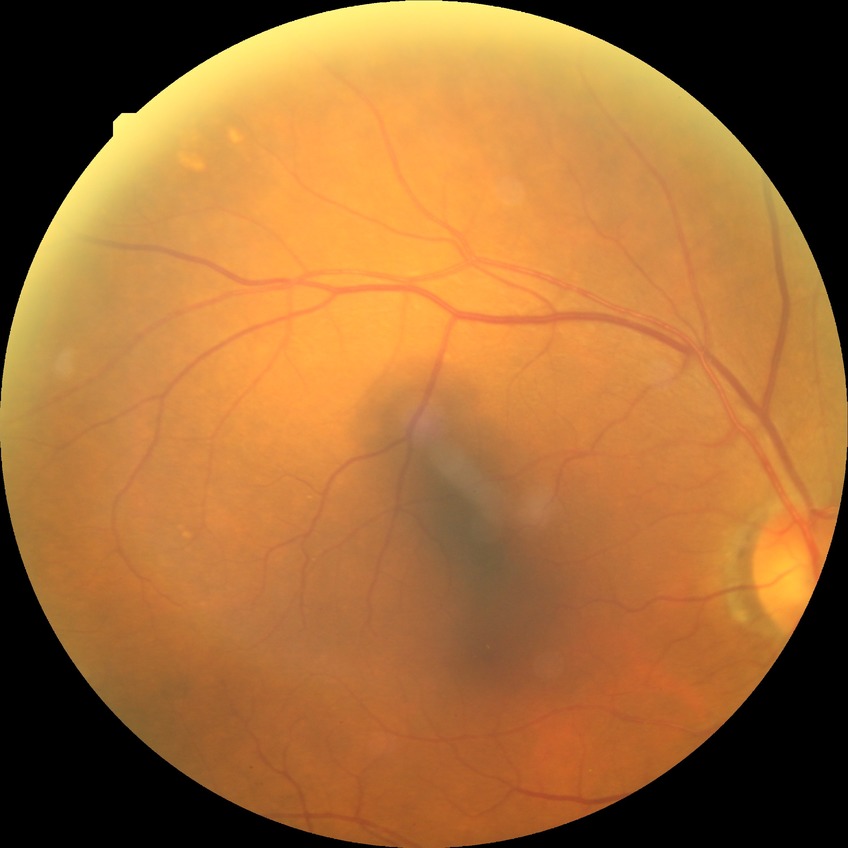 Retinopathy grade is no diabetic retinopathy.